1659 by 2212 pixels, Remidio Fundus on Phone — 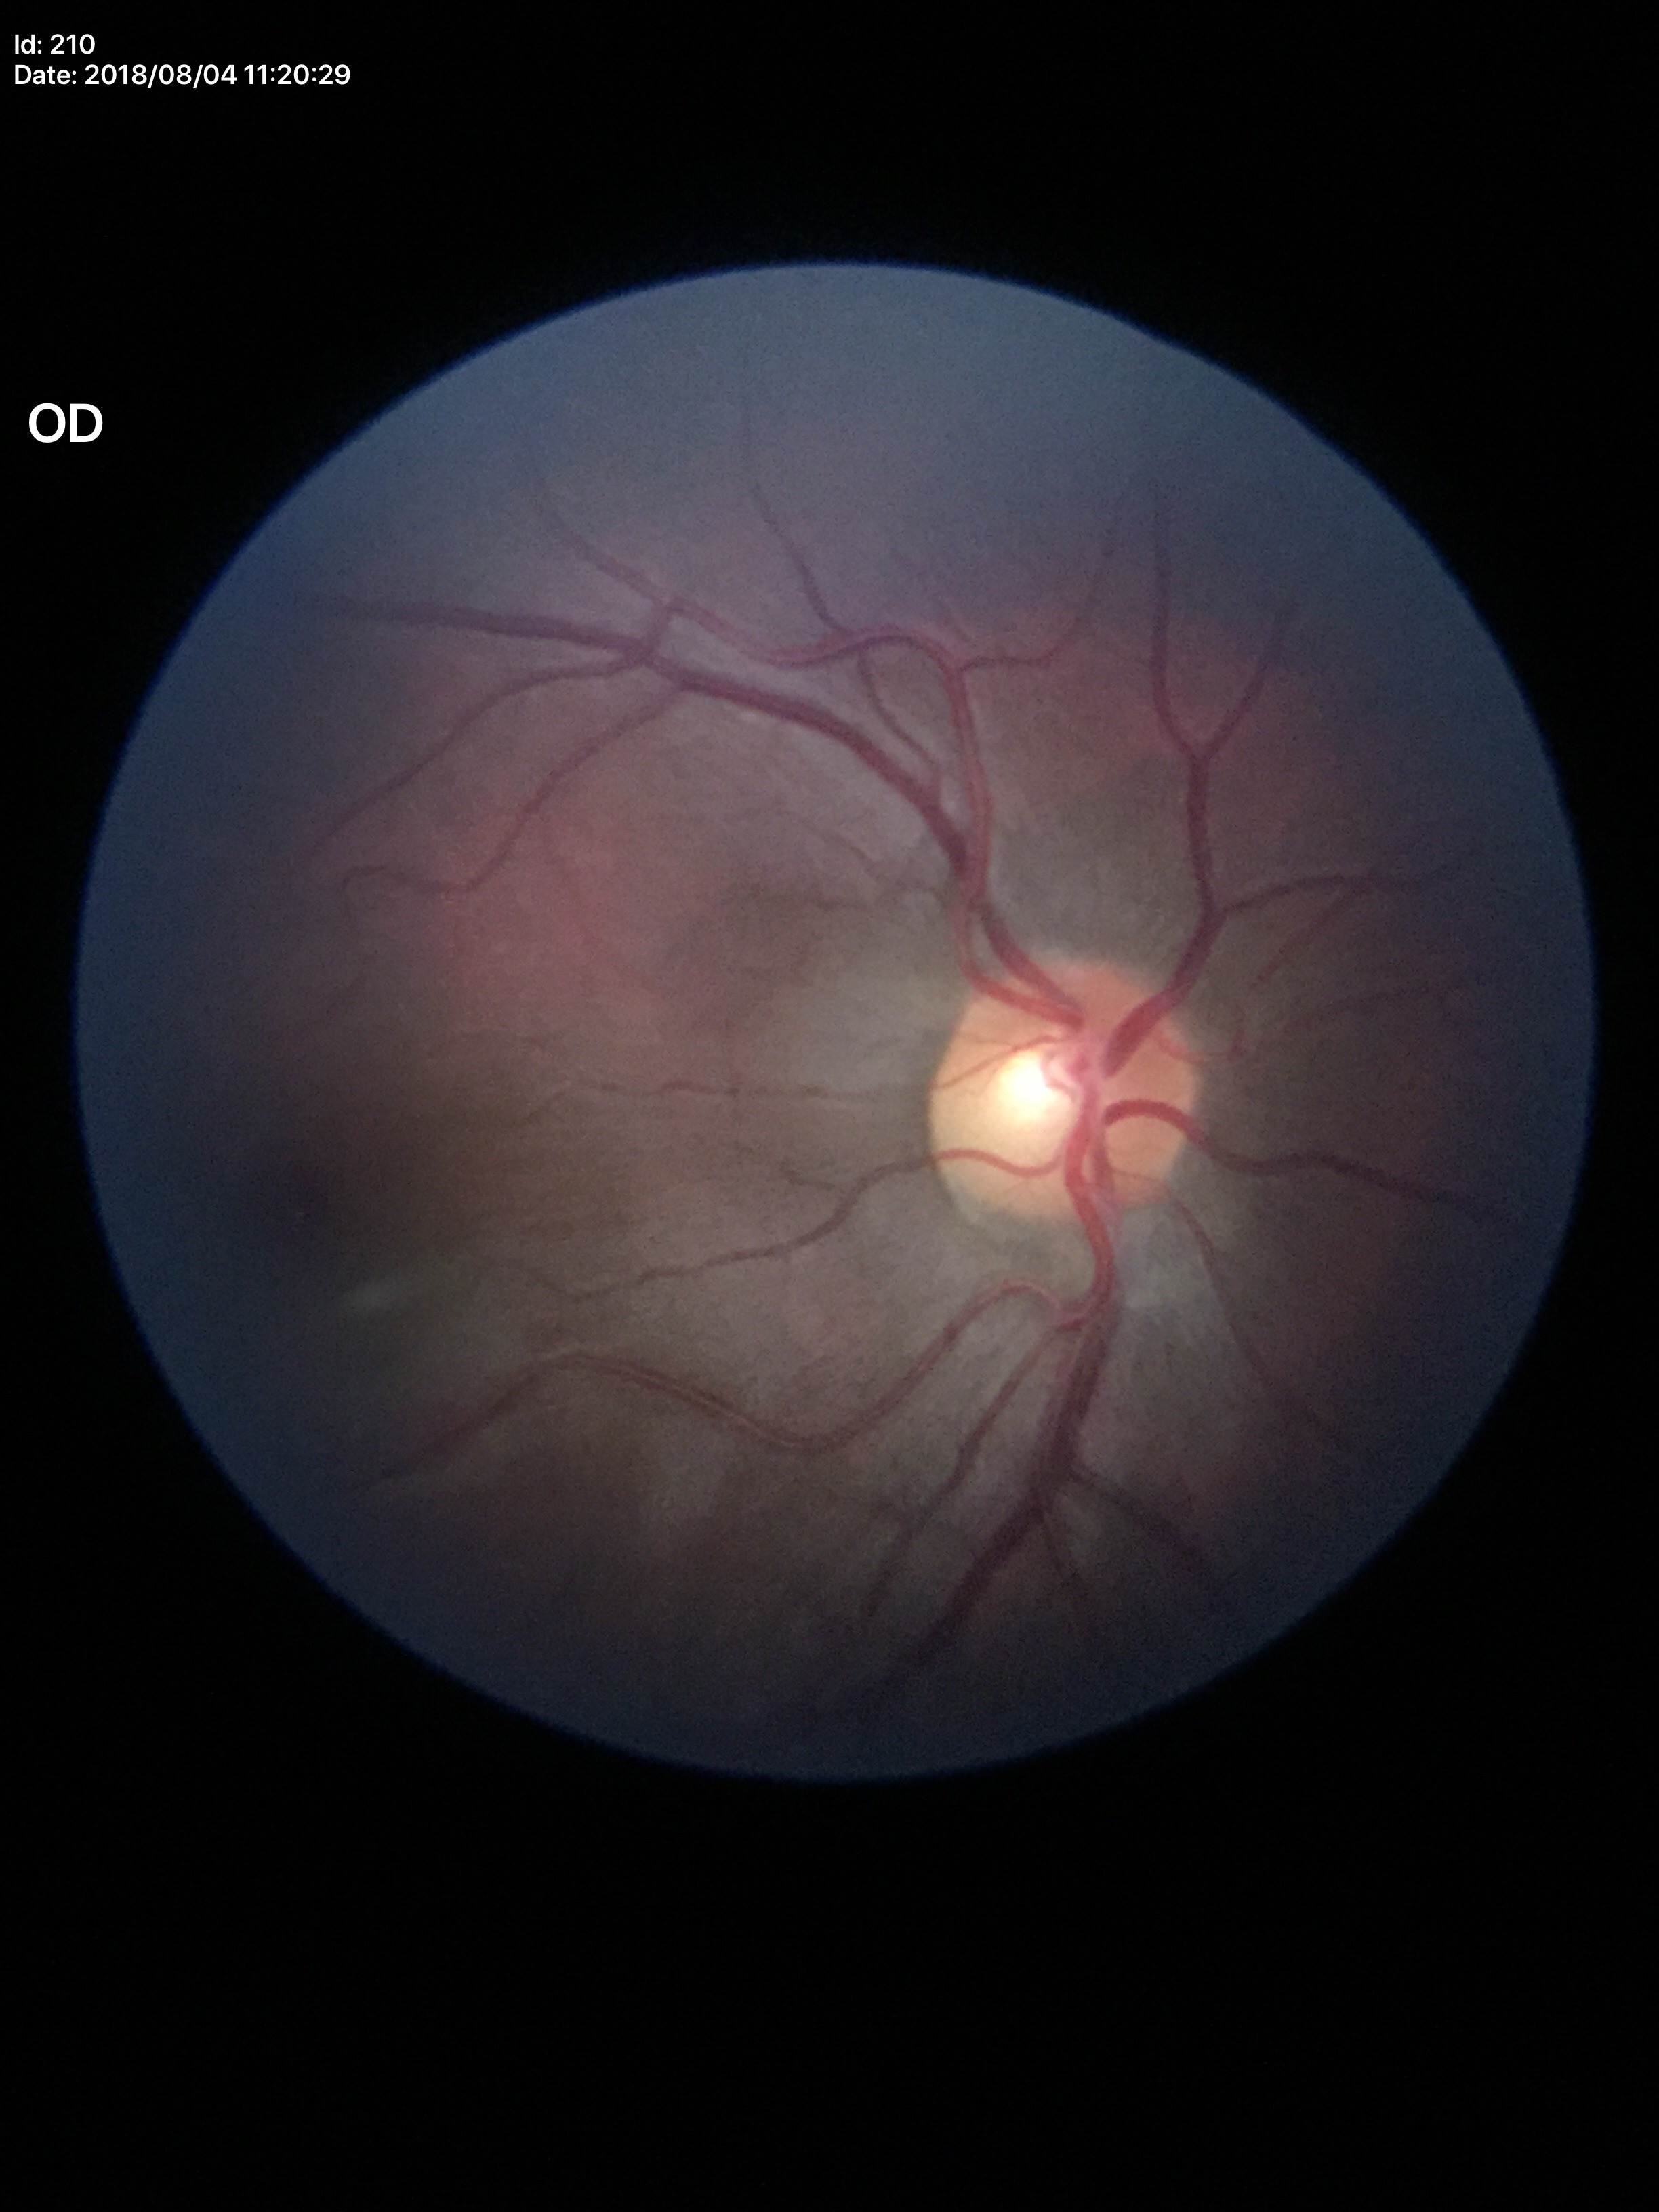 Glaucoma assessment=not suspect; HCDR=0.54; VCDR=0.52